FOV: 45 degrees: 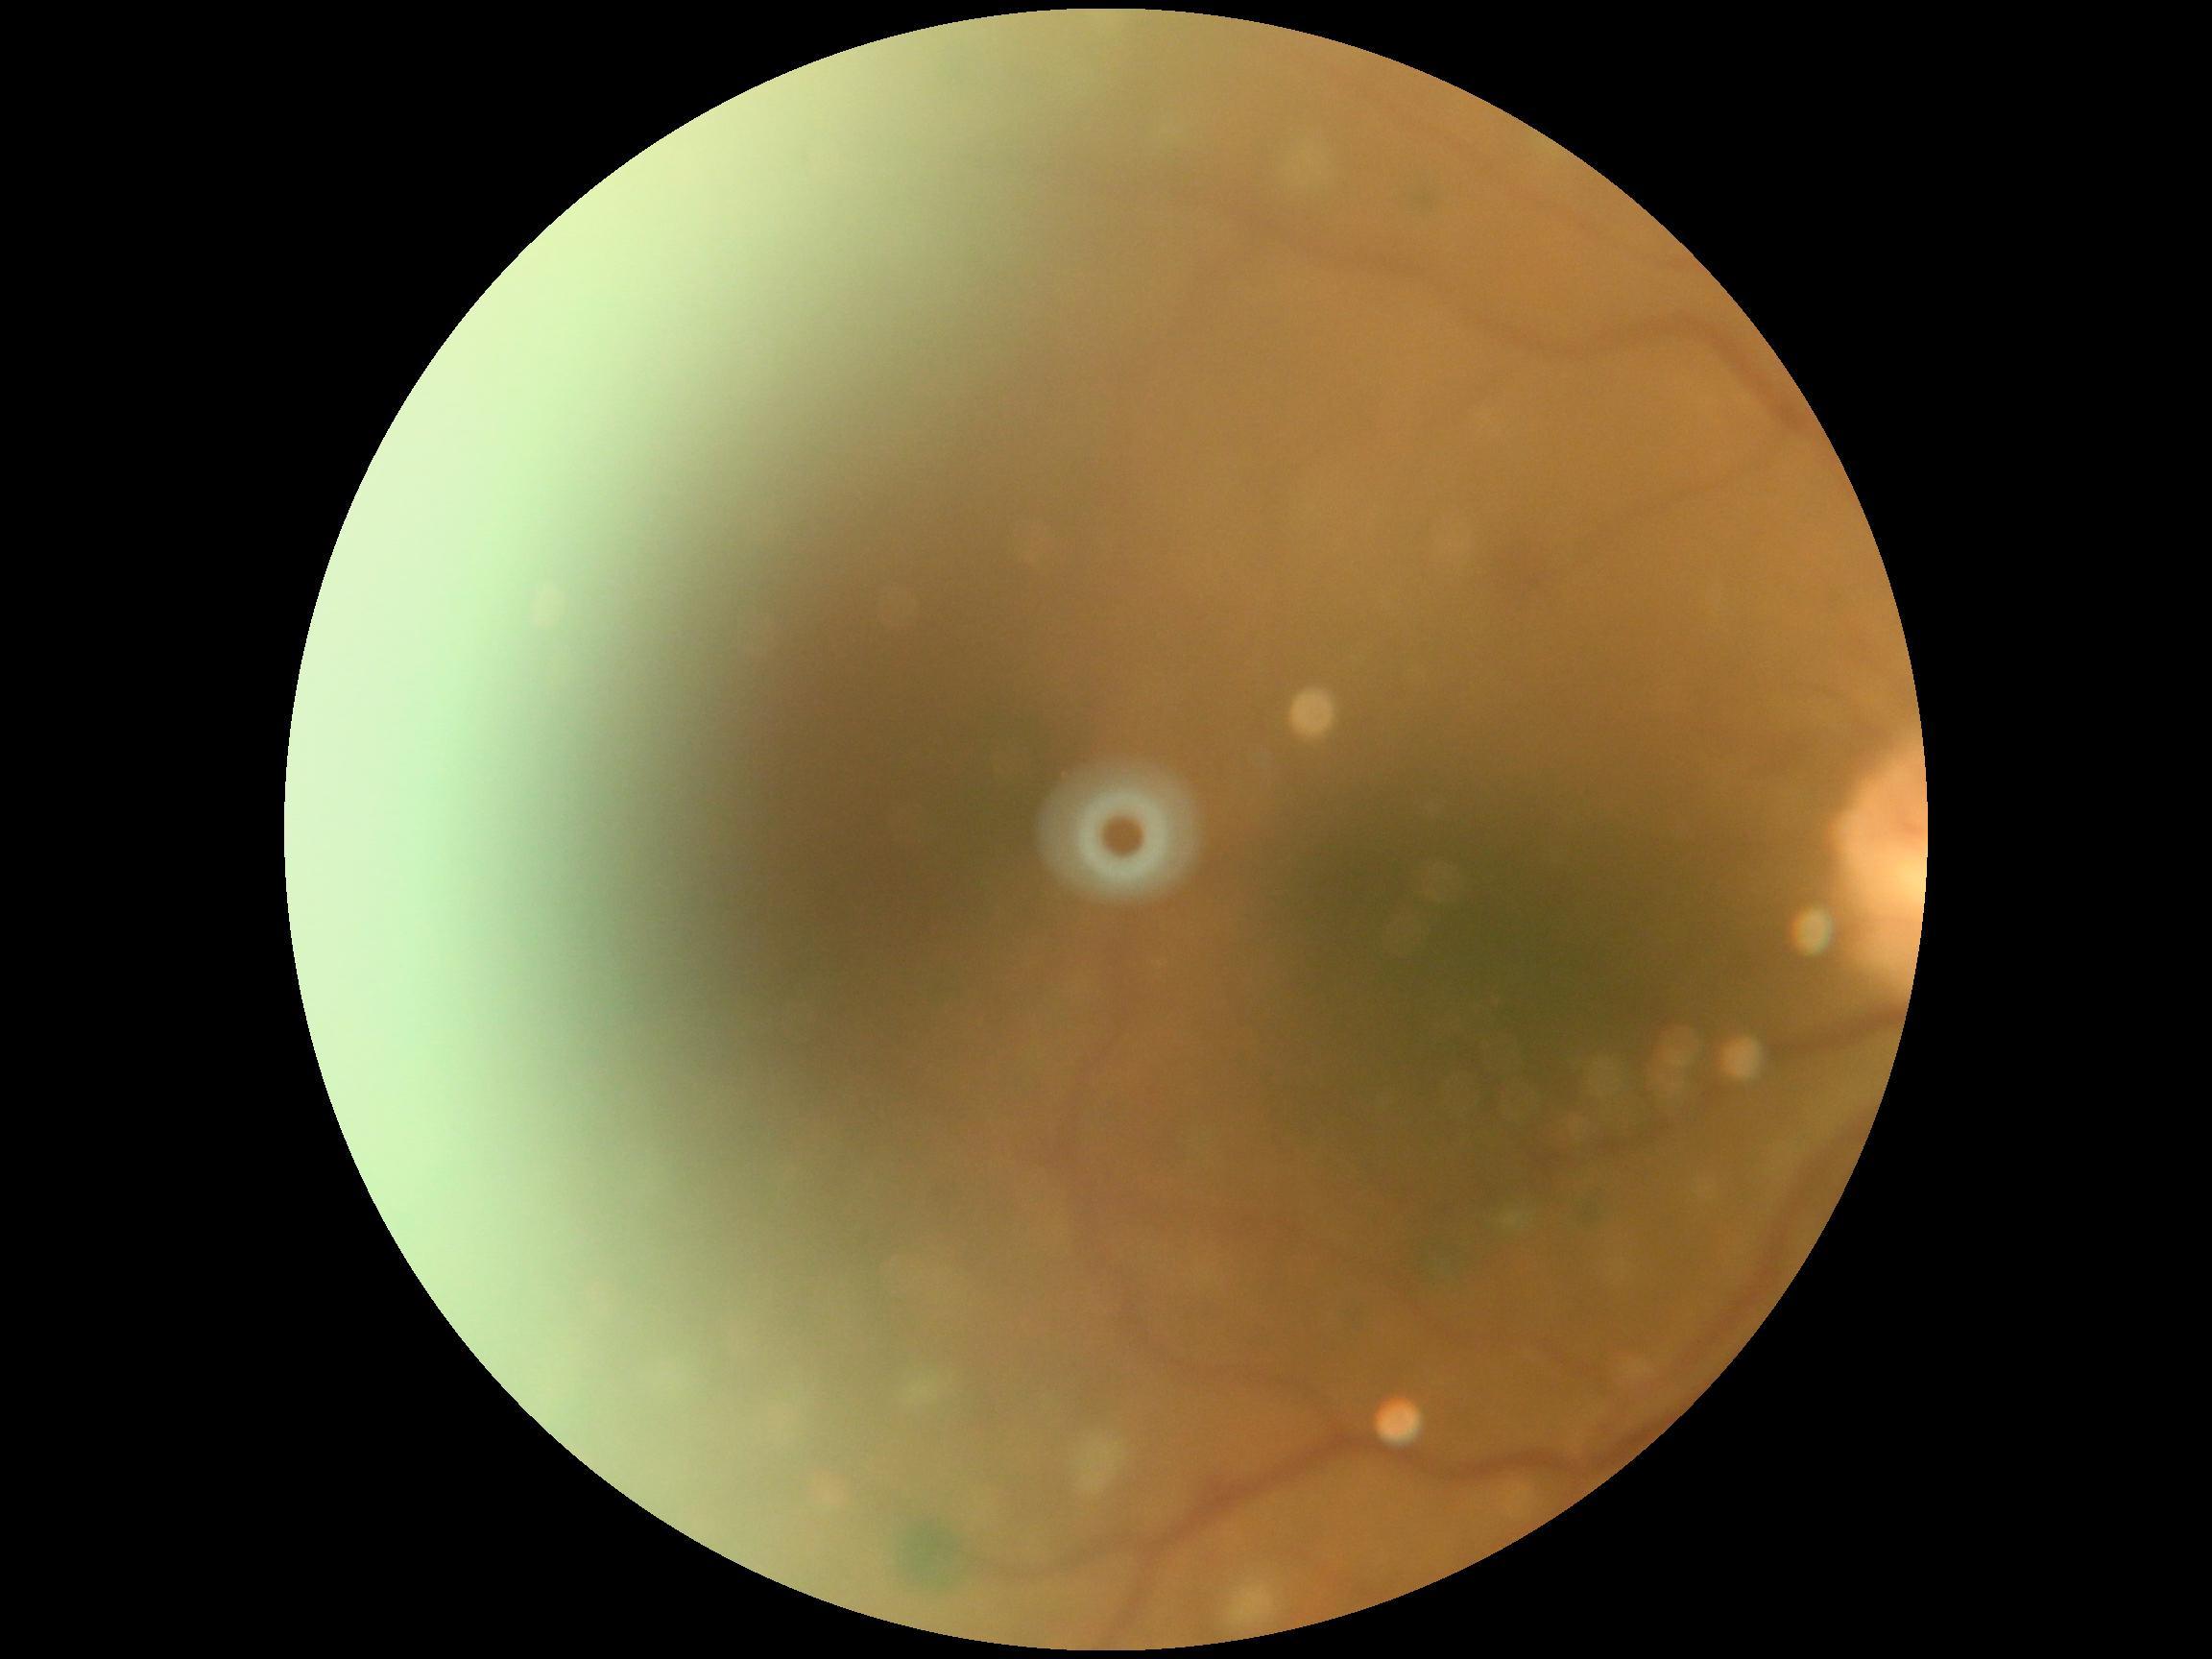
dr_grade: ungradable